Posterior pole color fundus photograph, 848 x 848 pixels, 45-degree field of view:
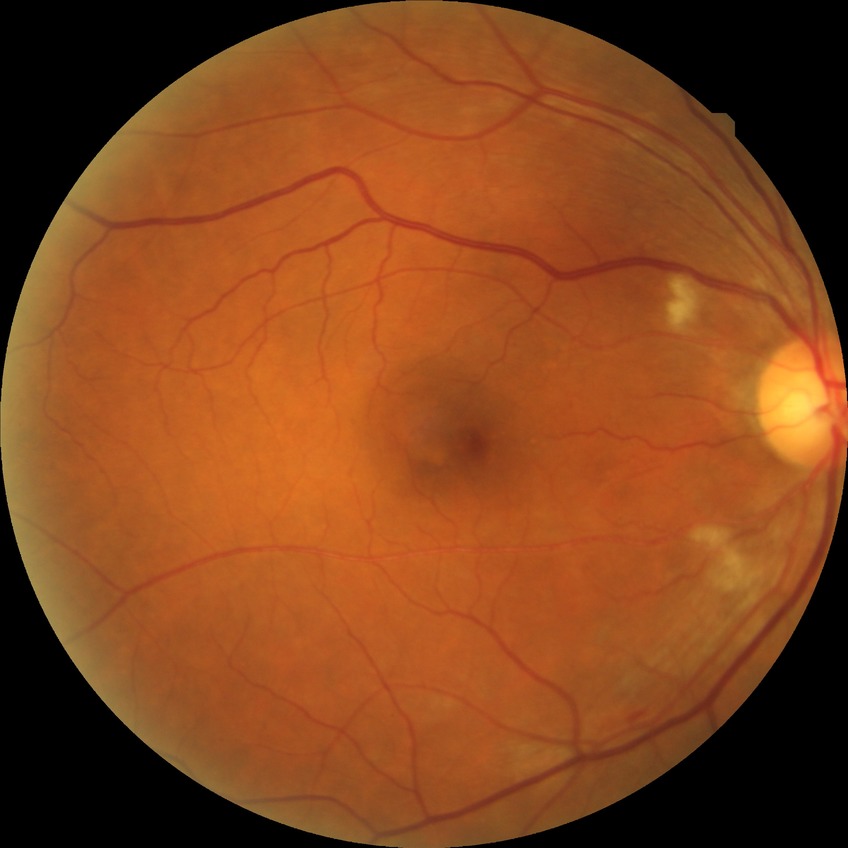
Diabetic retinopathy (DR): pre-proliferative diabetic retinopathy (PPDR).